Image size 1440x1080. Pediatric retinal photograph (wide-field). Captured with the Natus RetCam Envision (130° field of view) — 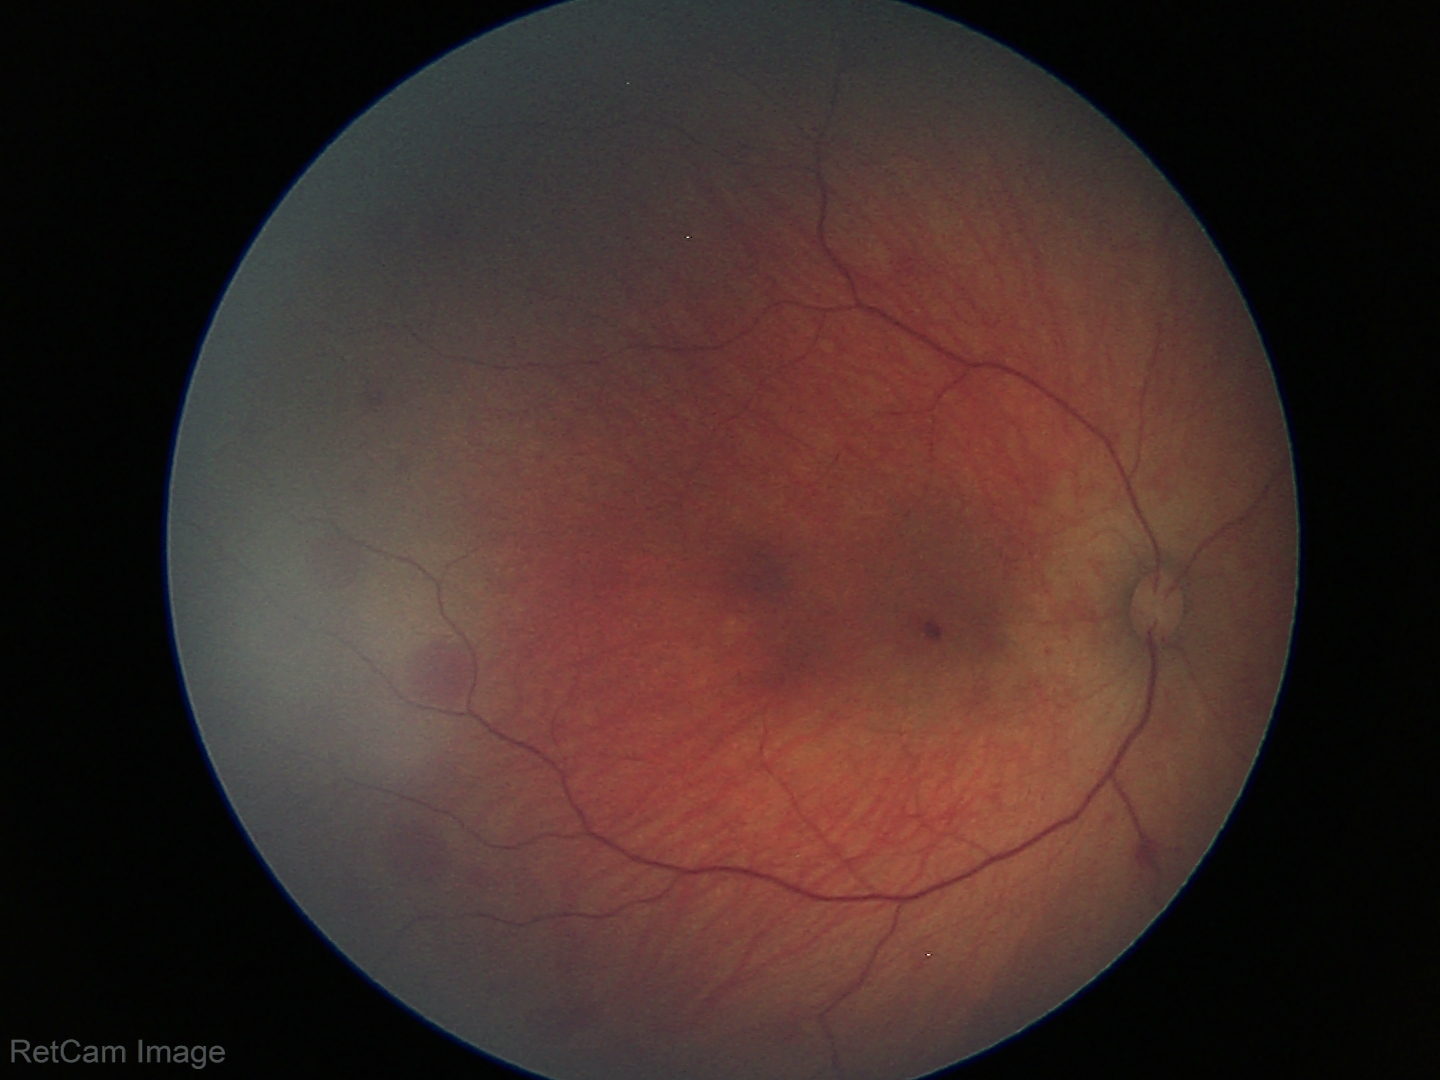

Screening series with retinal hemorrhages.